FOV: 45 degrees:
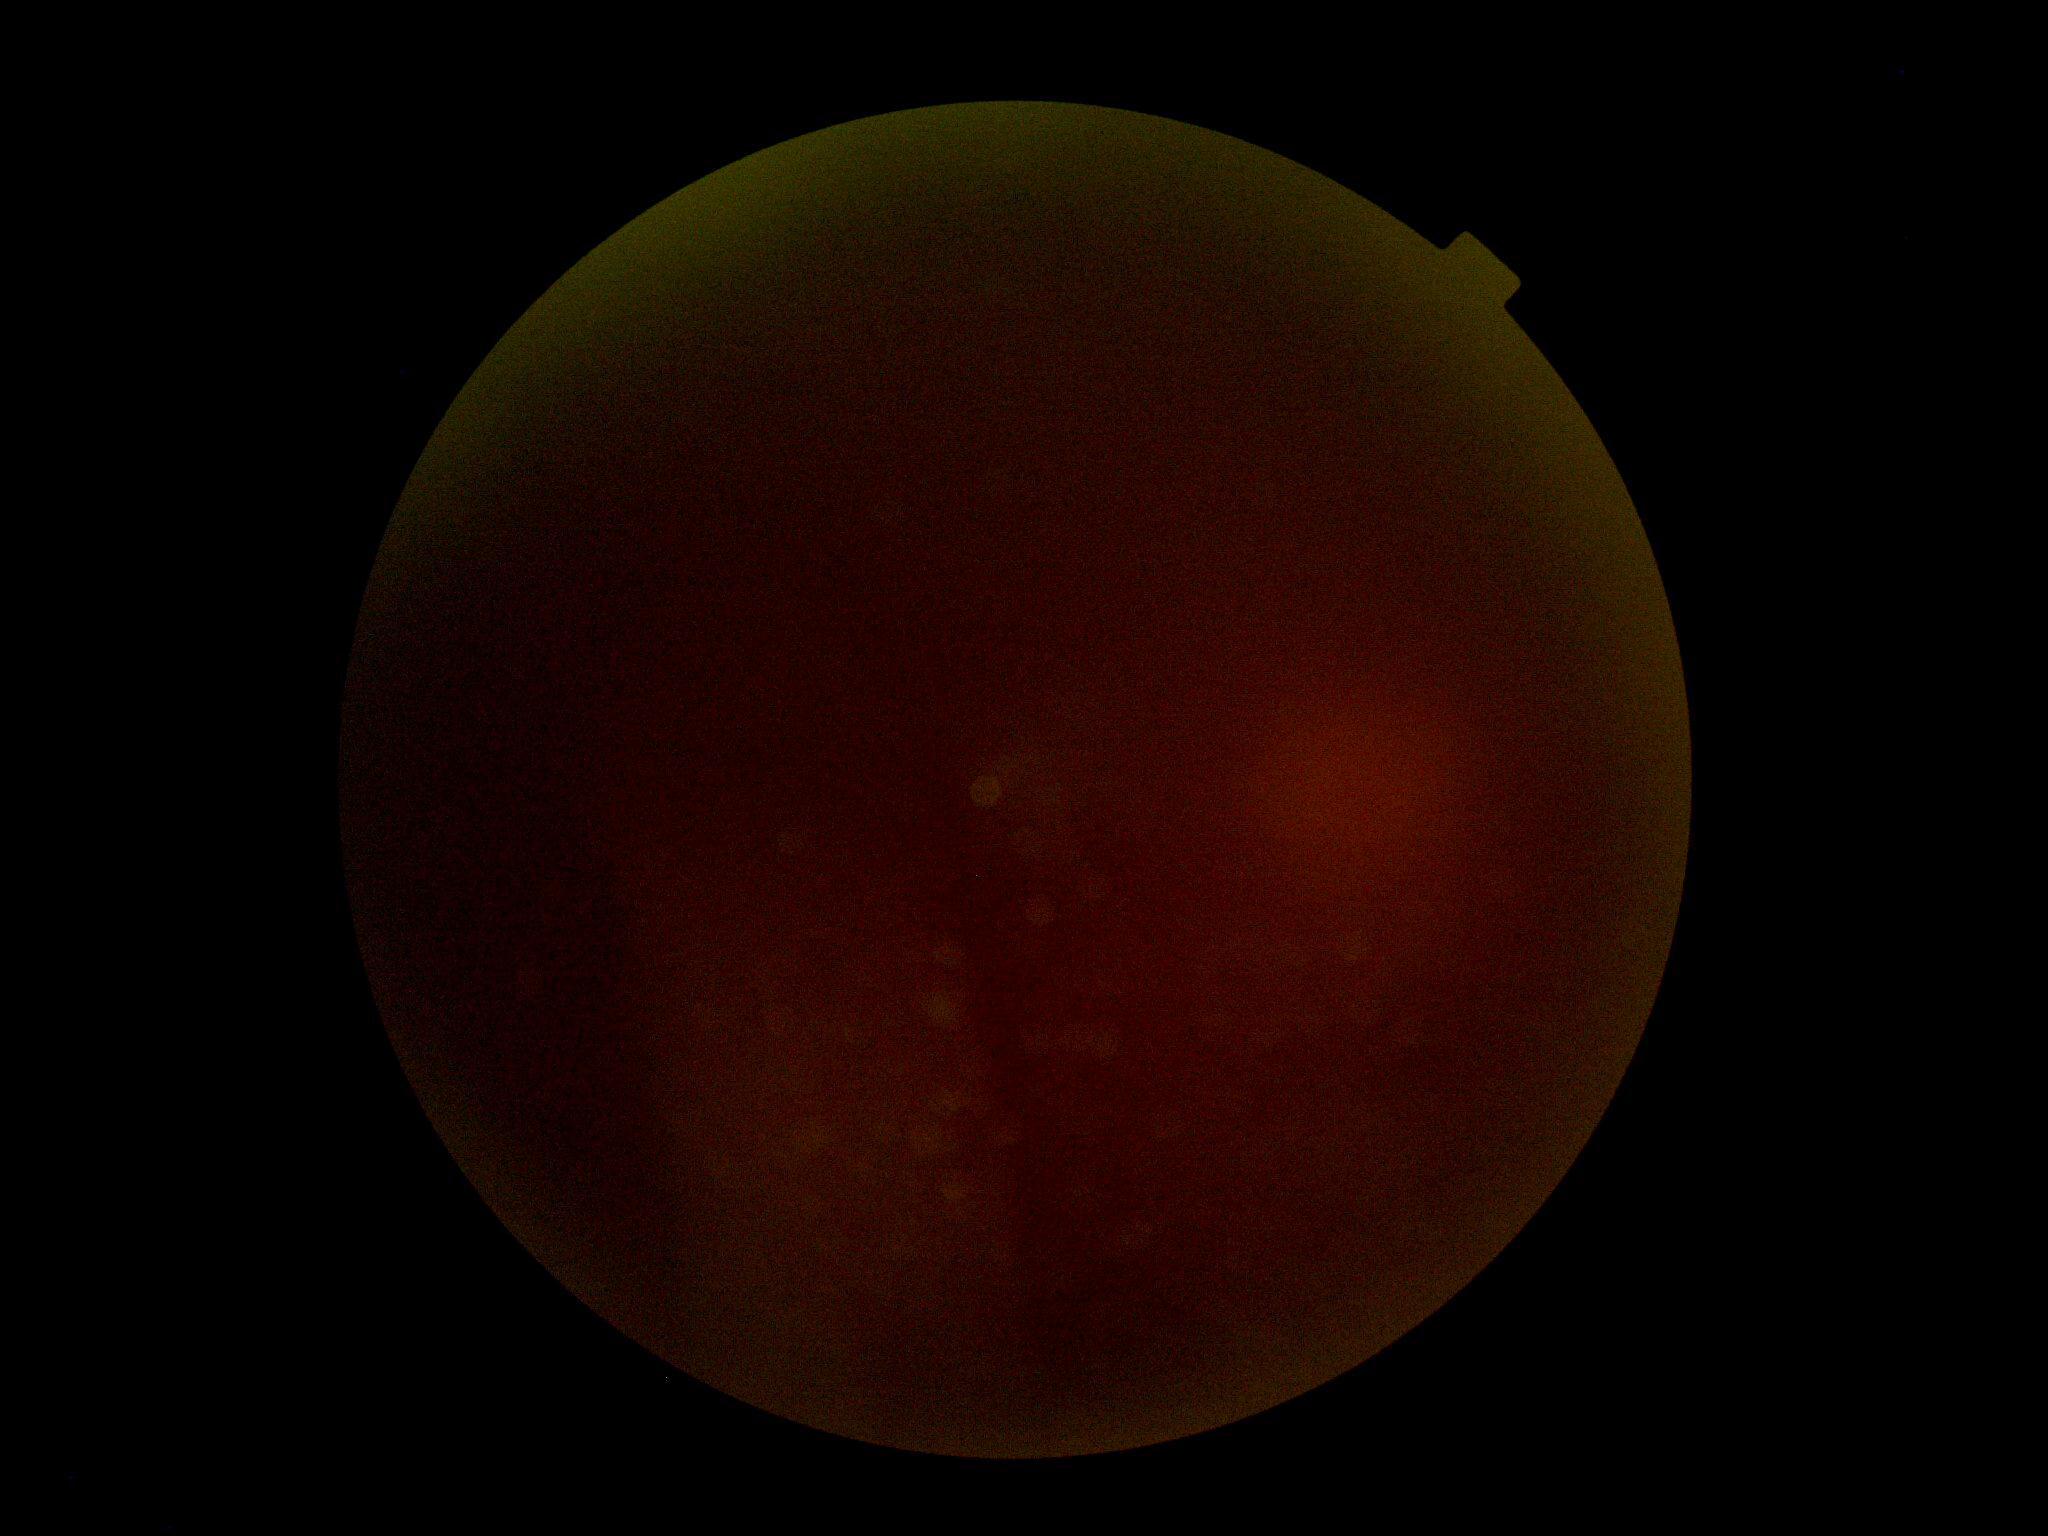

{
  "dr_grade": "ungradable"
}